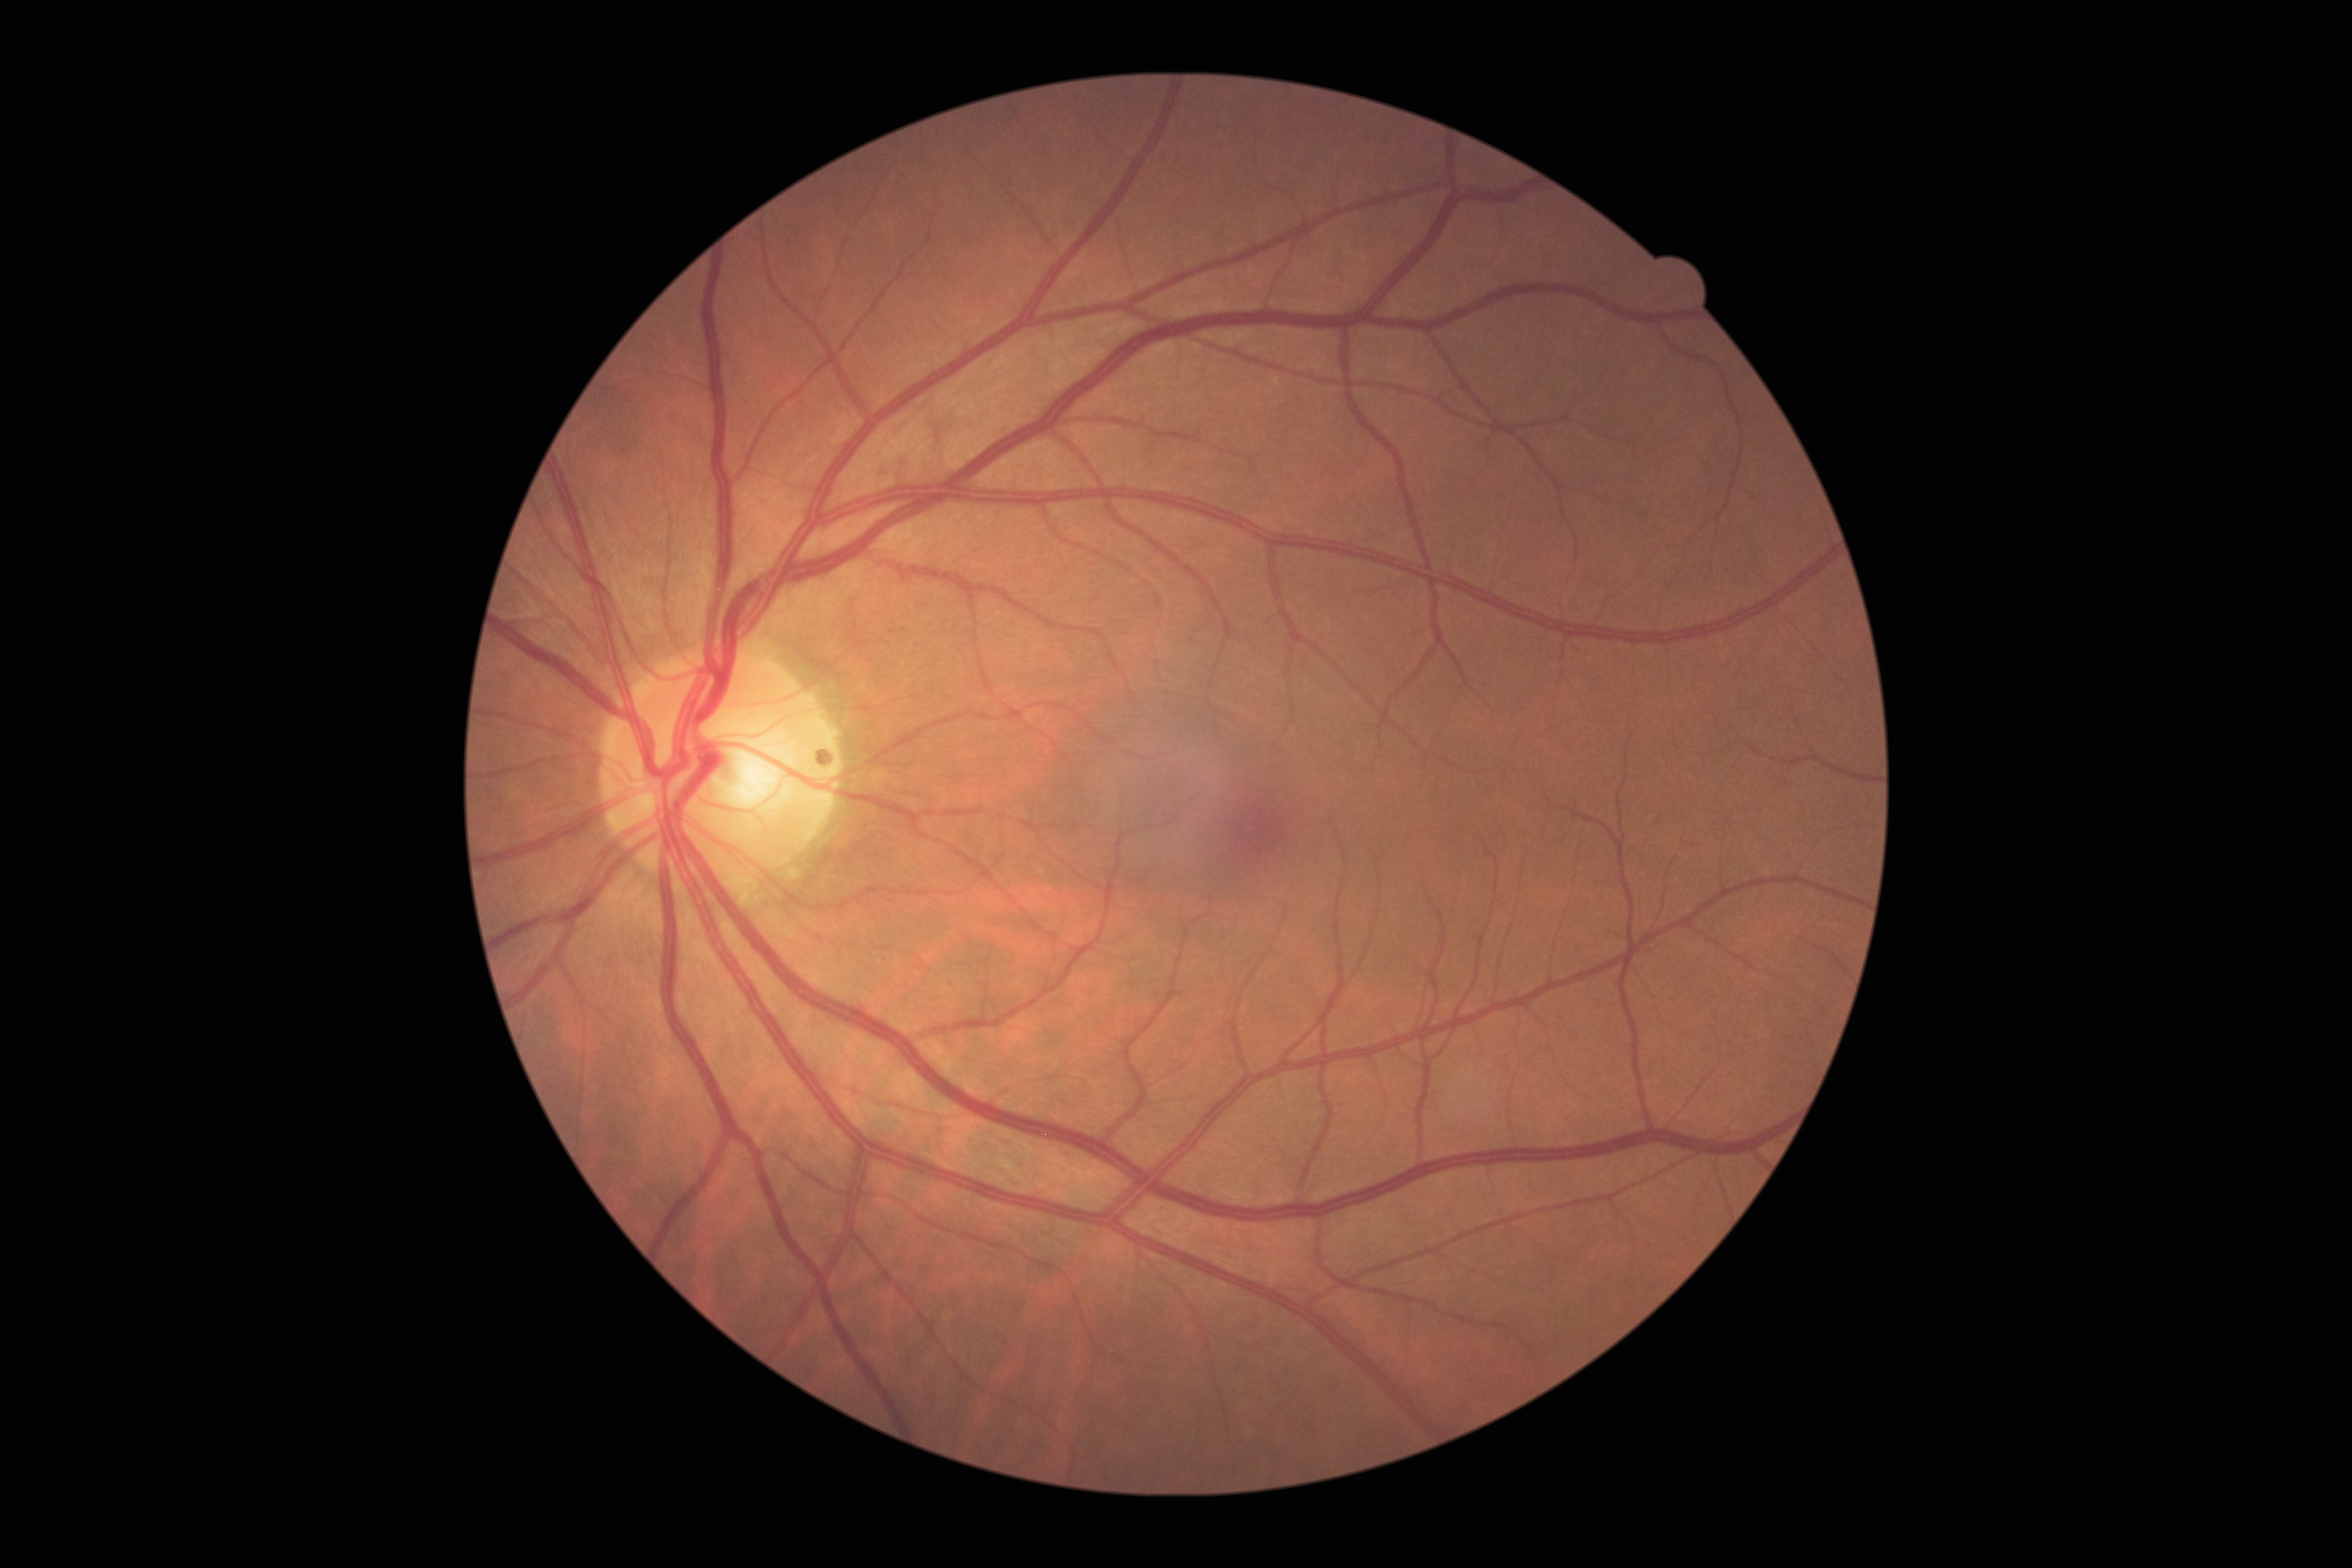
DR severity: grade 0 (no apparent retinopathy).